Wide-field fundus image from infant ROP screening; 640 x 480 pixels: 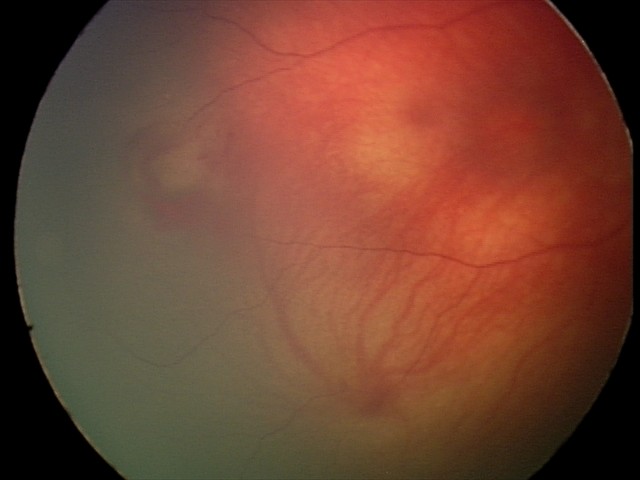
Diagnosis from this screening exam: retinal hemorrhages.